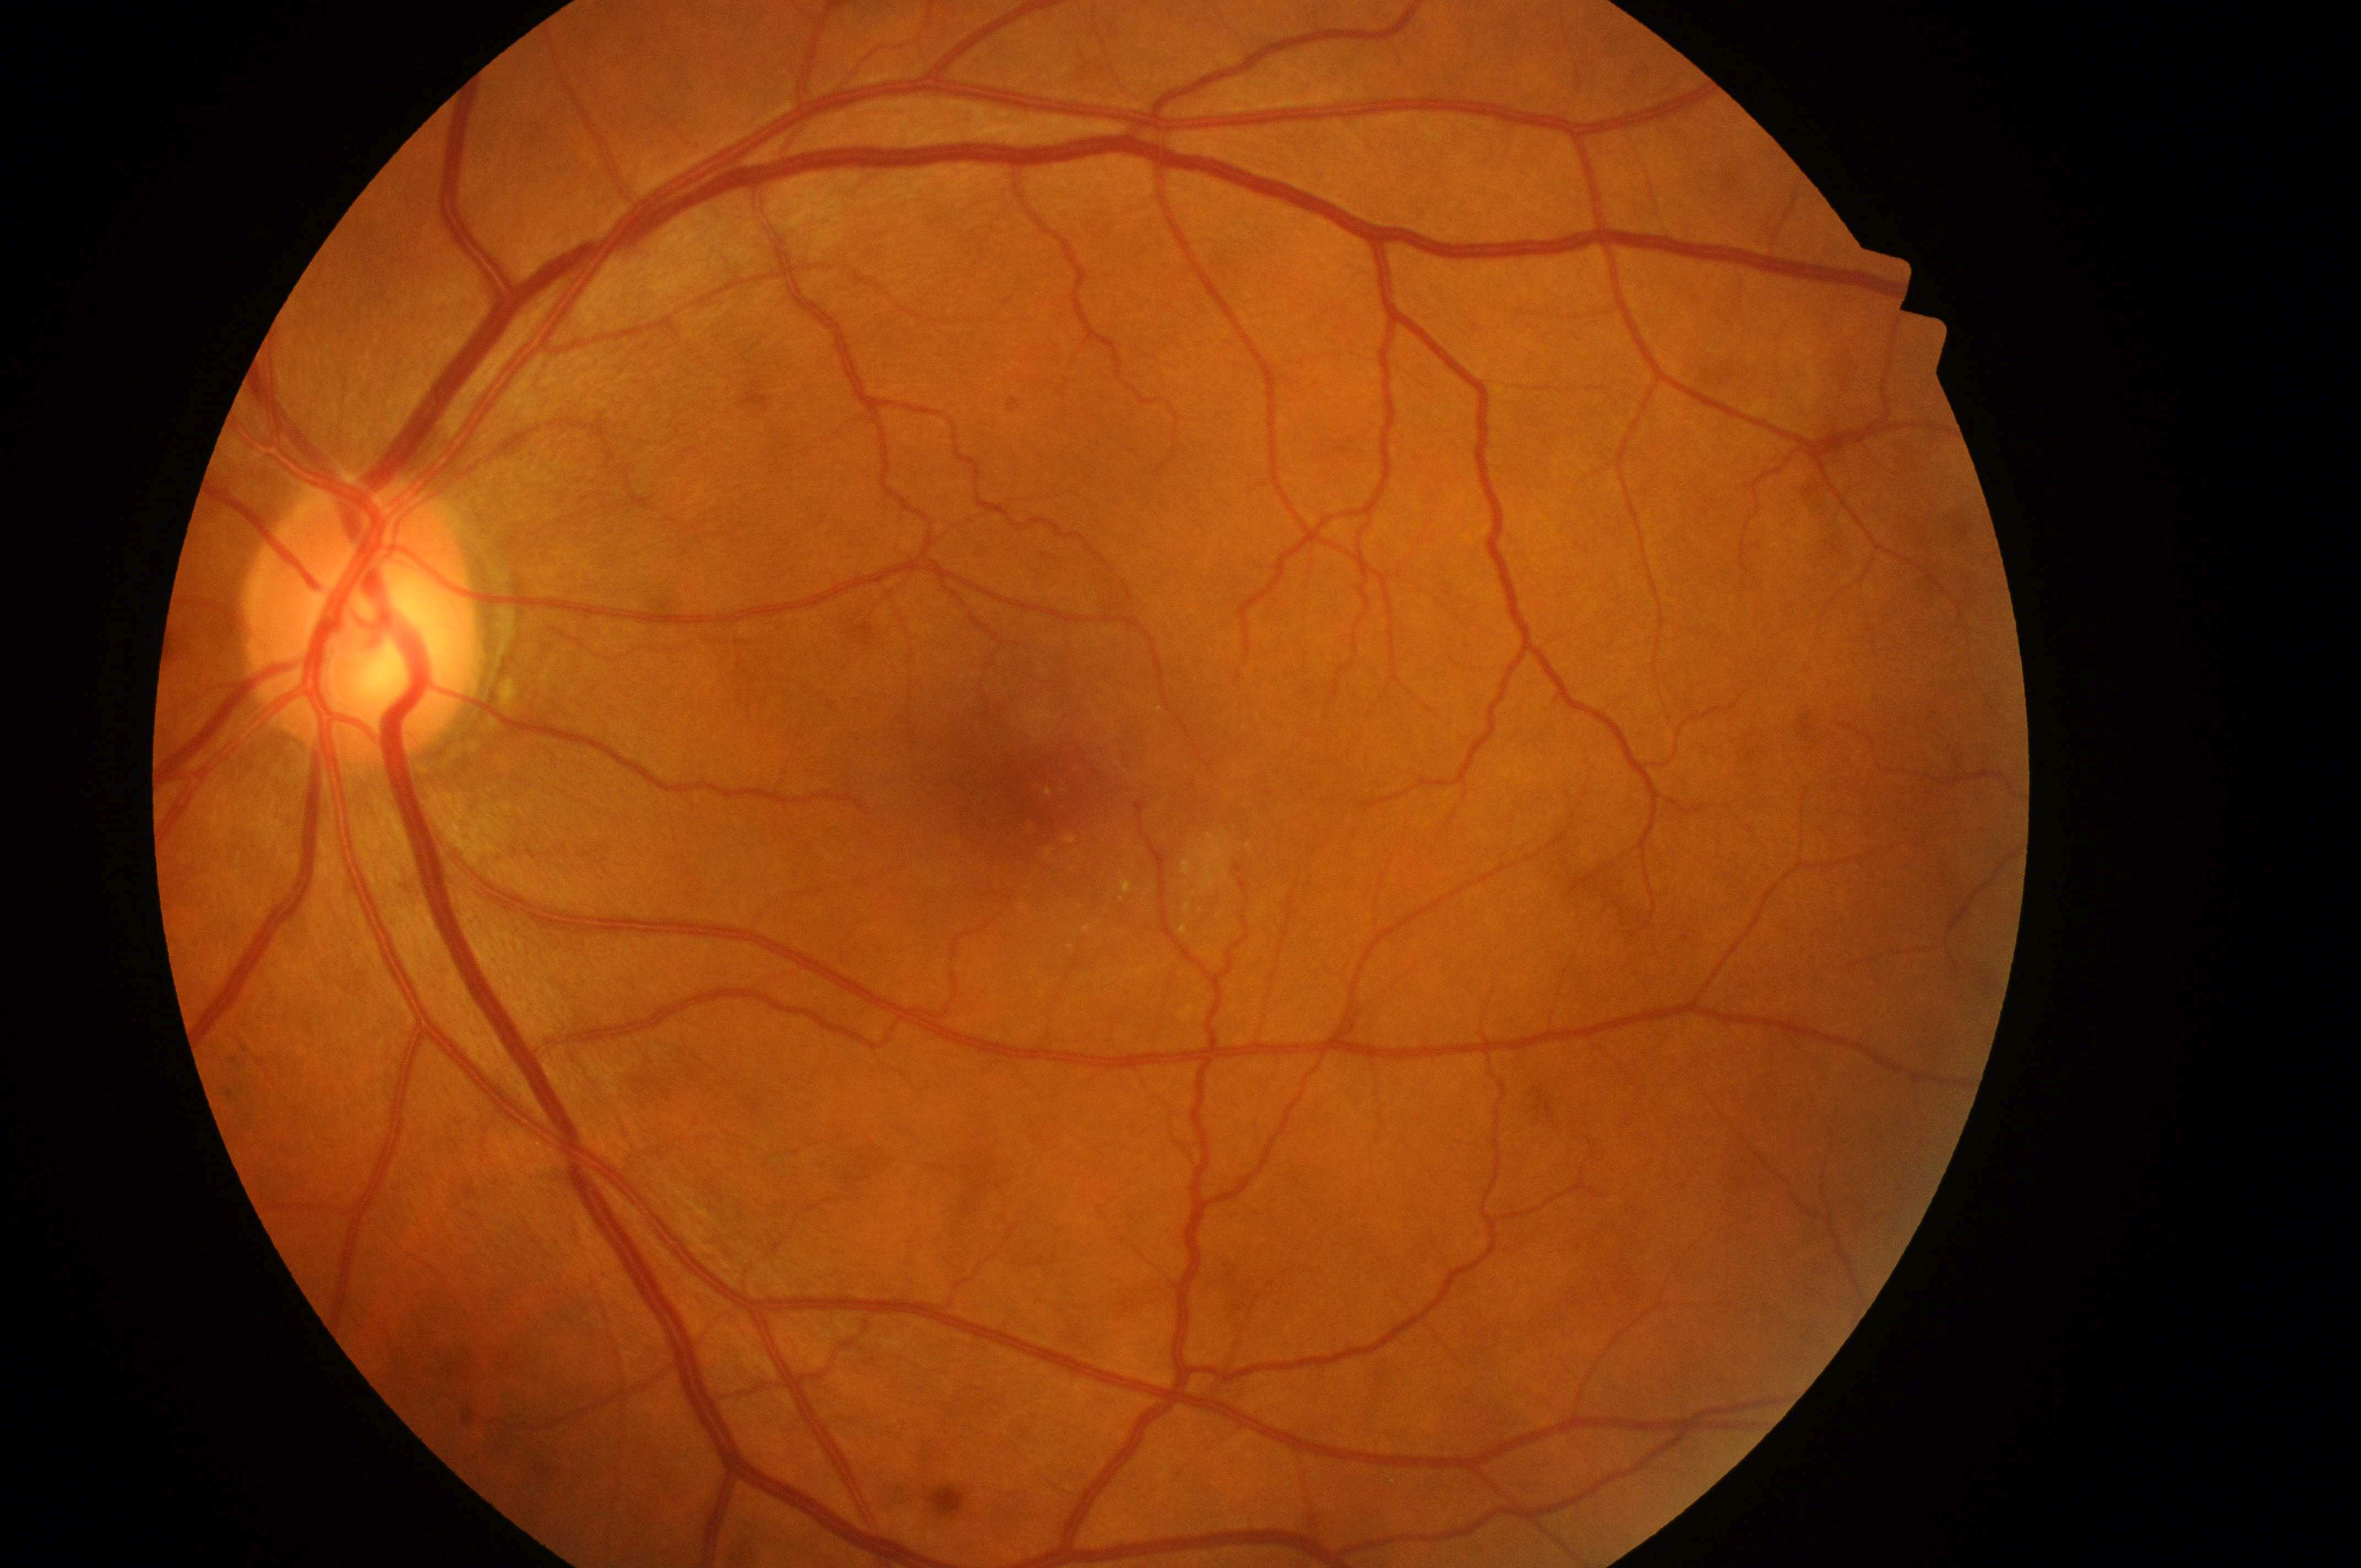

• fovea centralis · [1027, 798]
• laterality · the left eye
• optic disc center · [356, 633]
• macular edema · 2/2
• retinopathy · grade 2